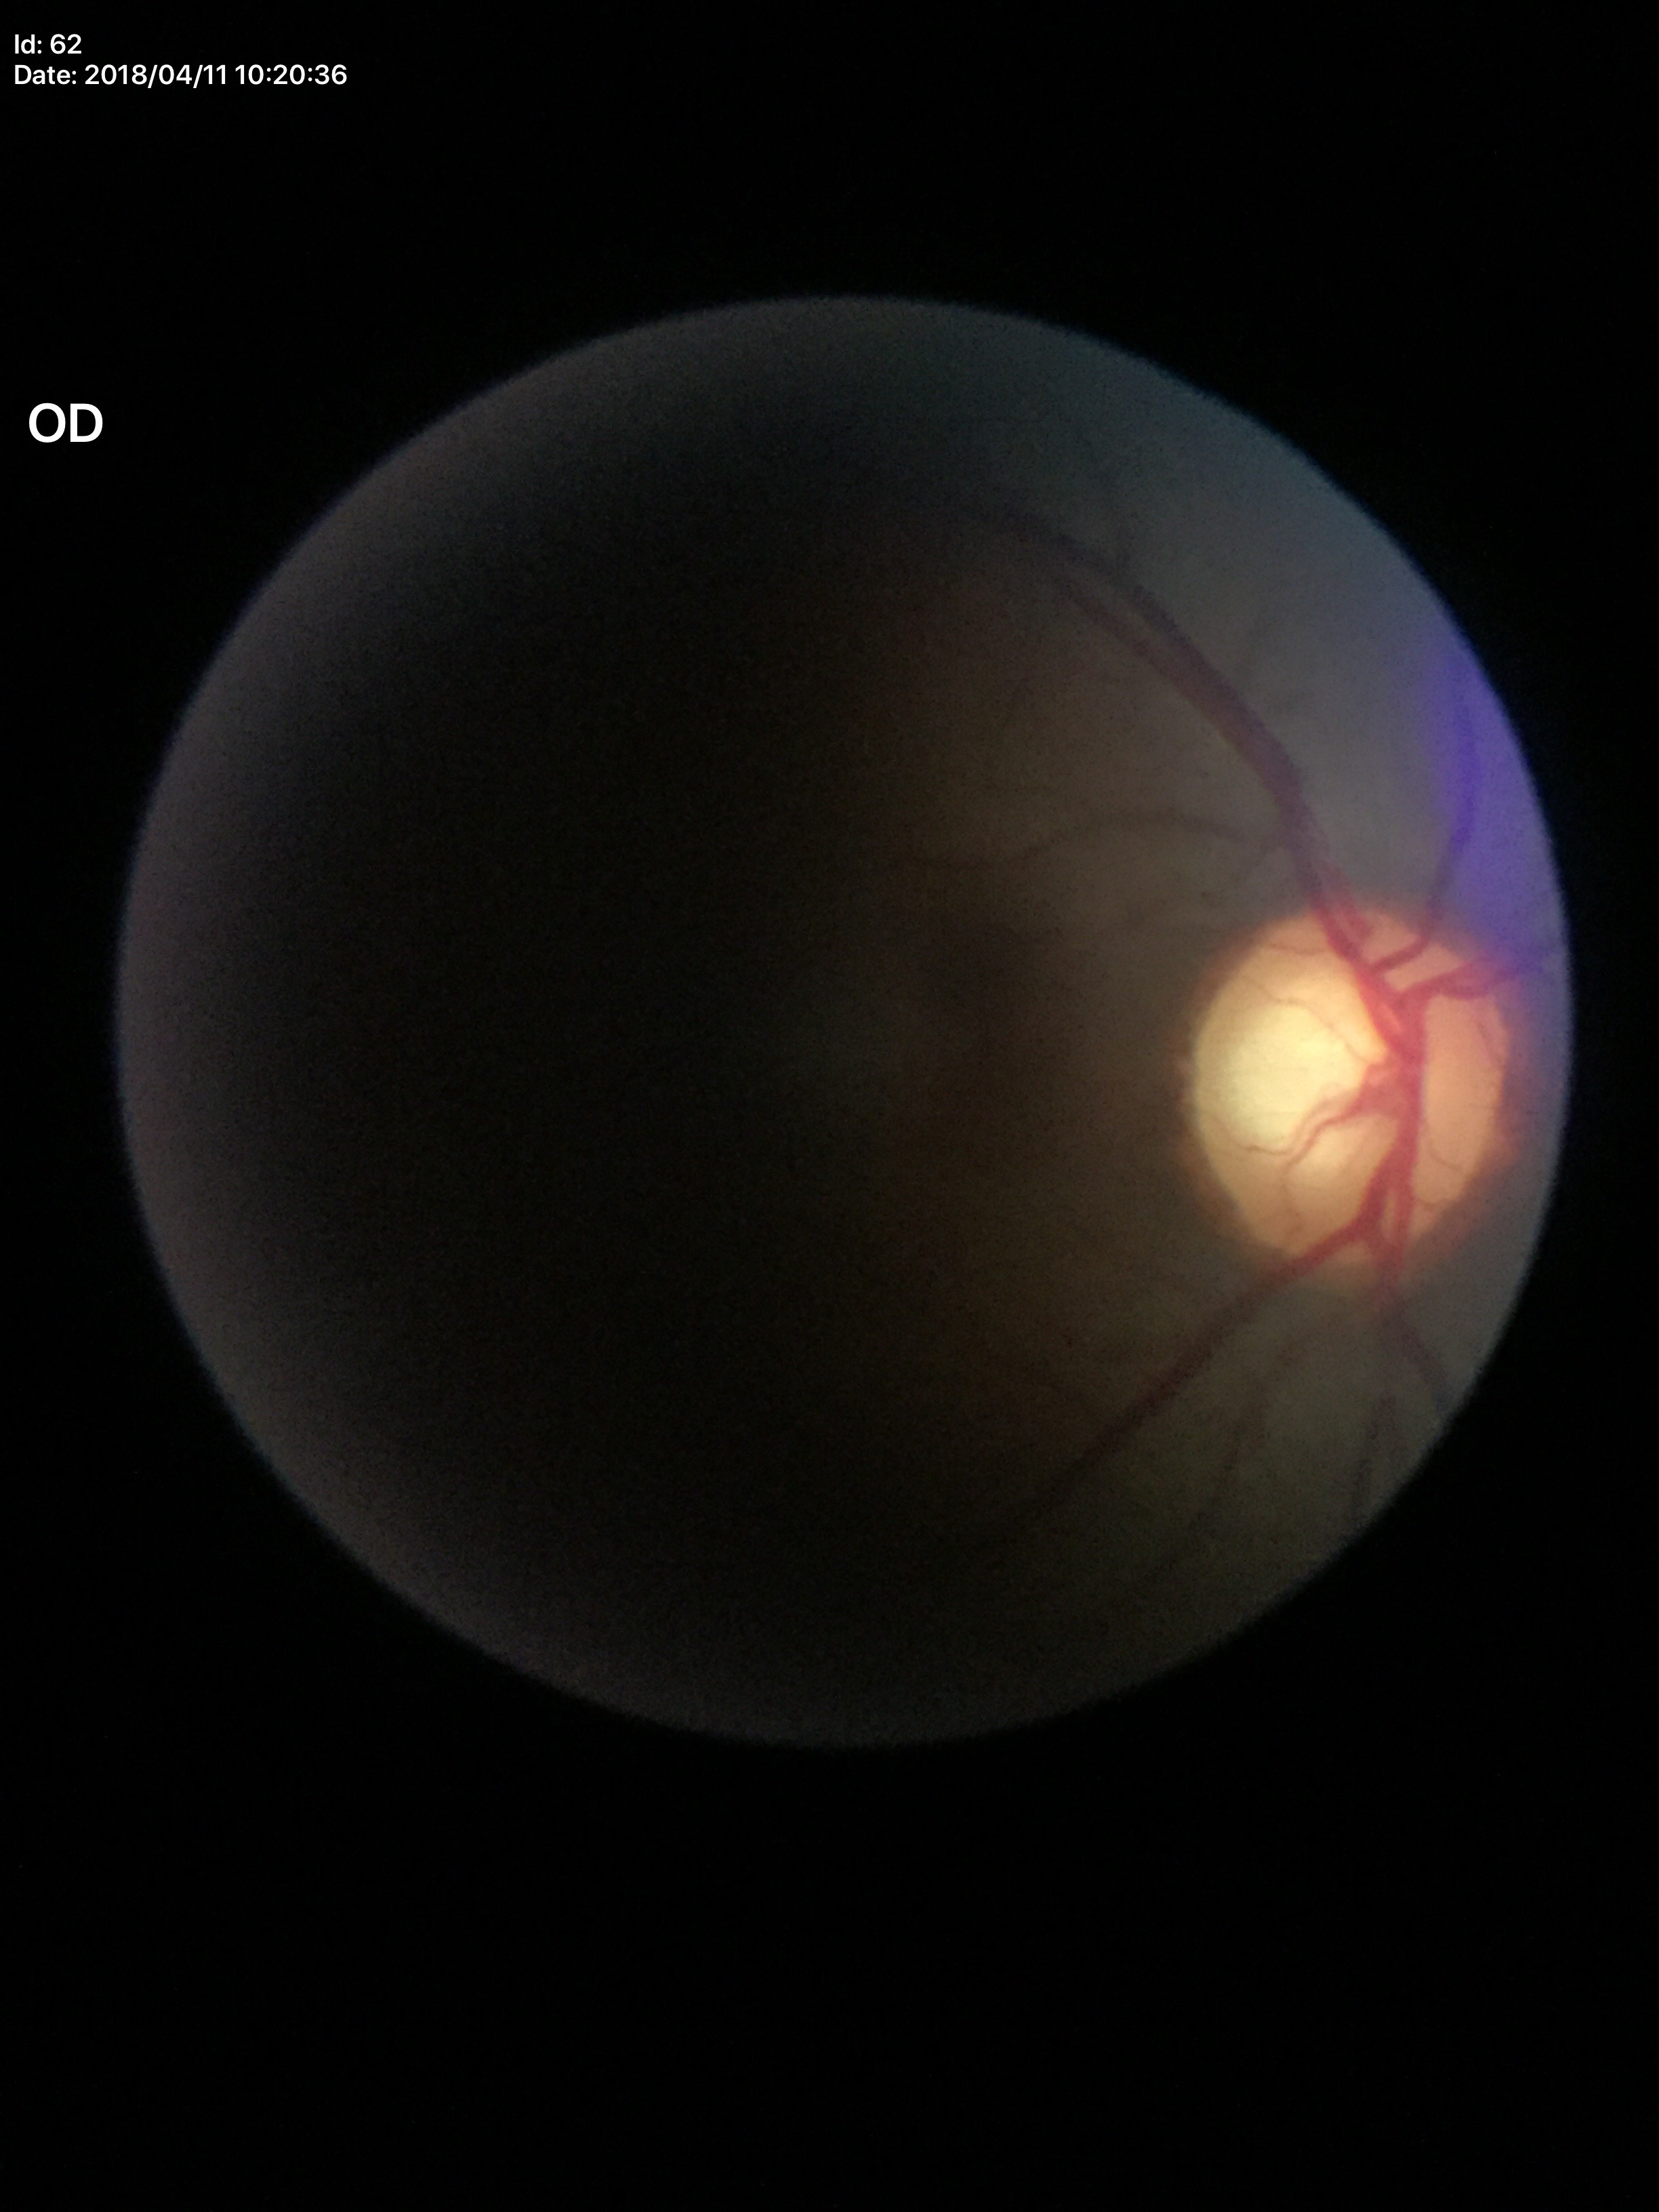
Optic disc analysis:
* Glaucoma screening — suspicious findings (5/5 ophthalmologists in agreement)
* VCDR — 0.71
* ACDR — 0.49